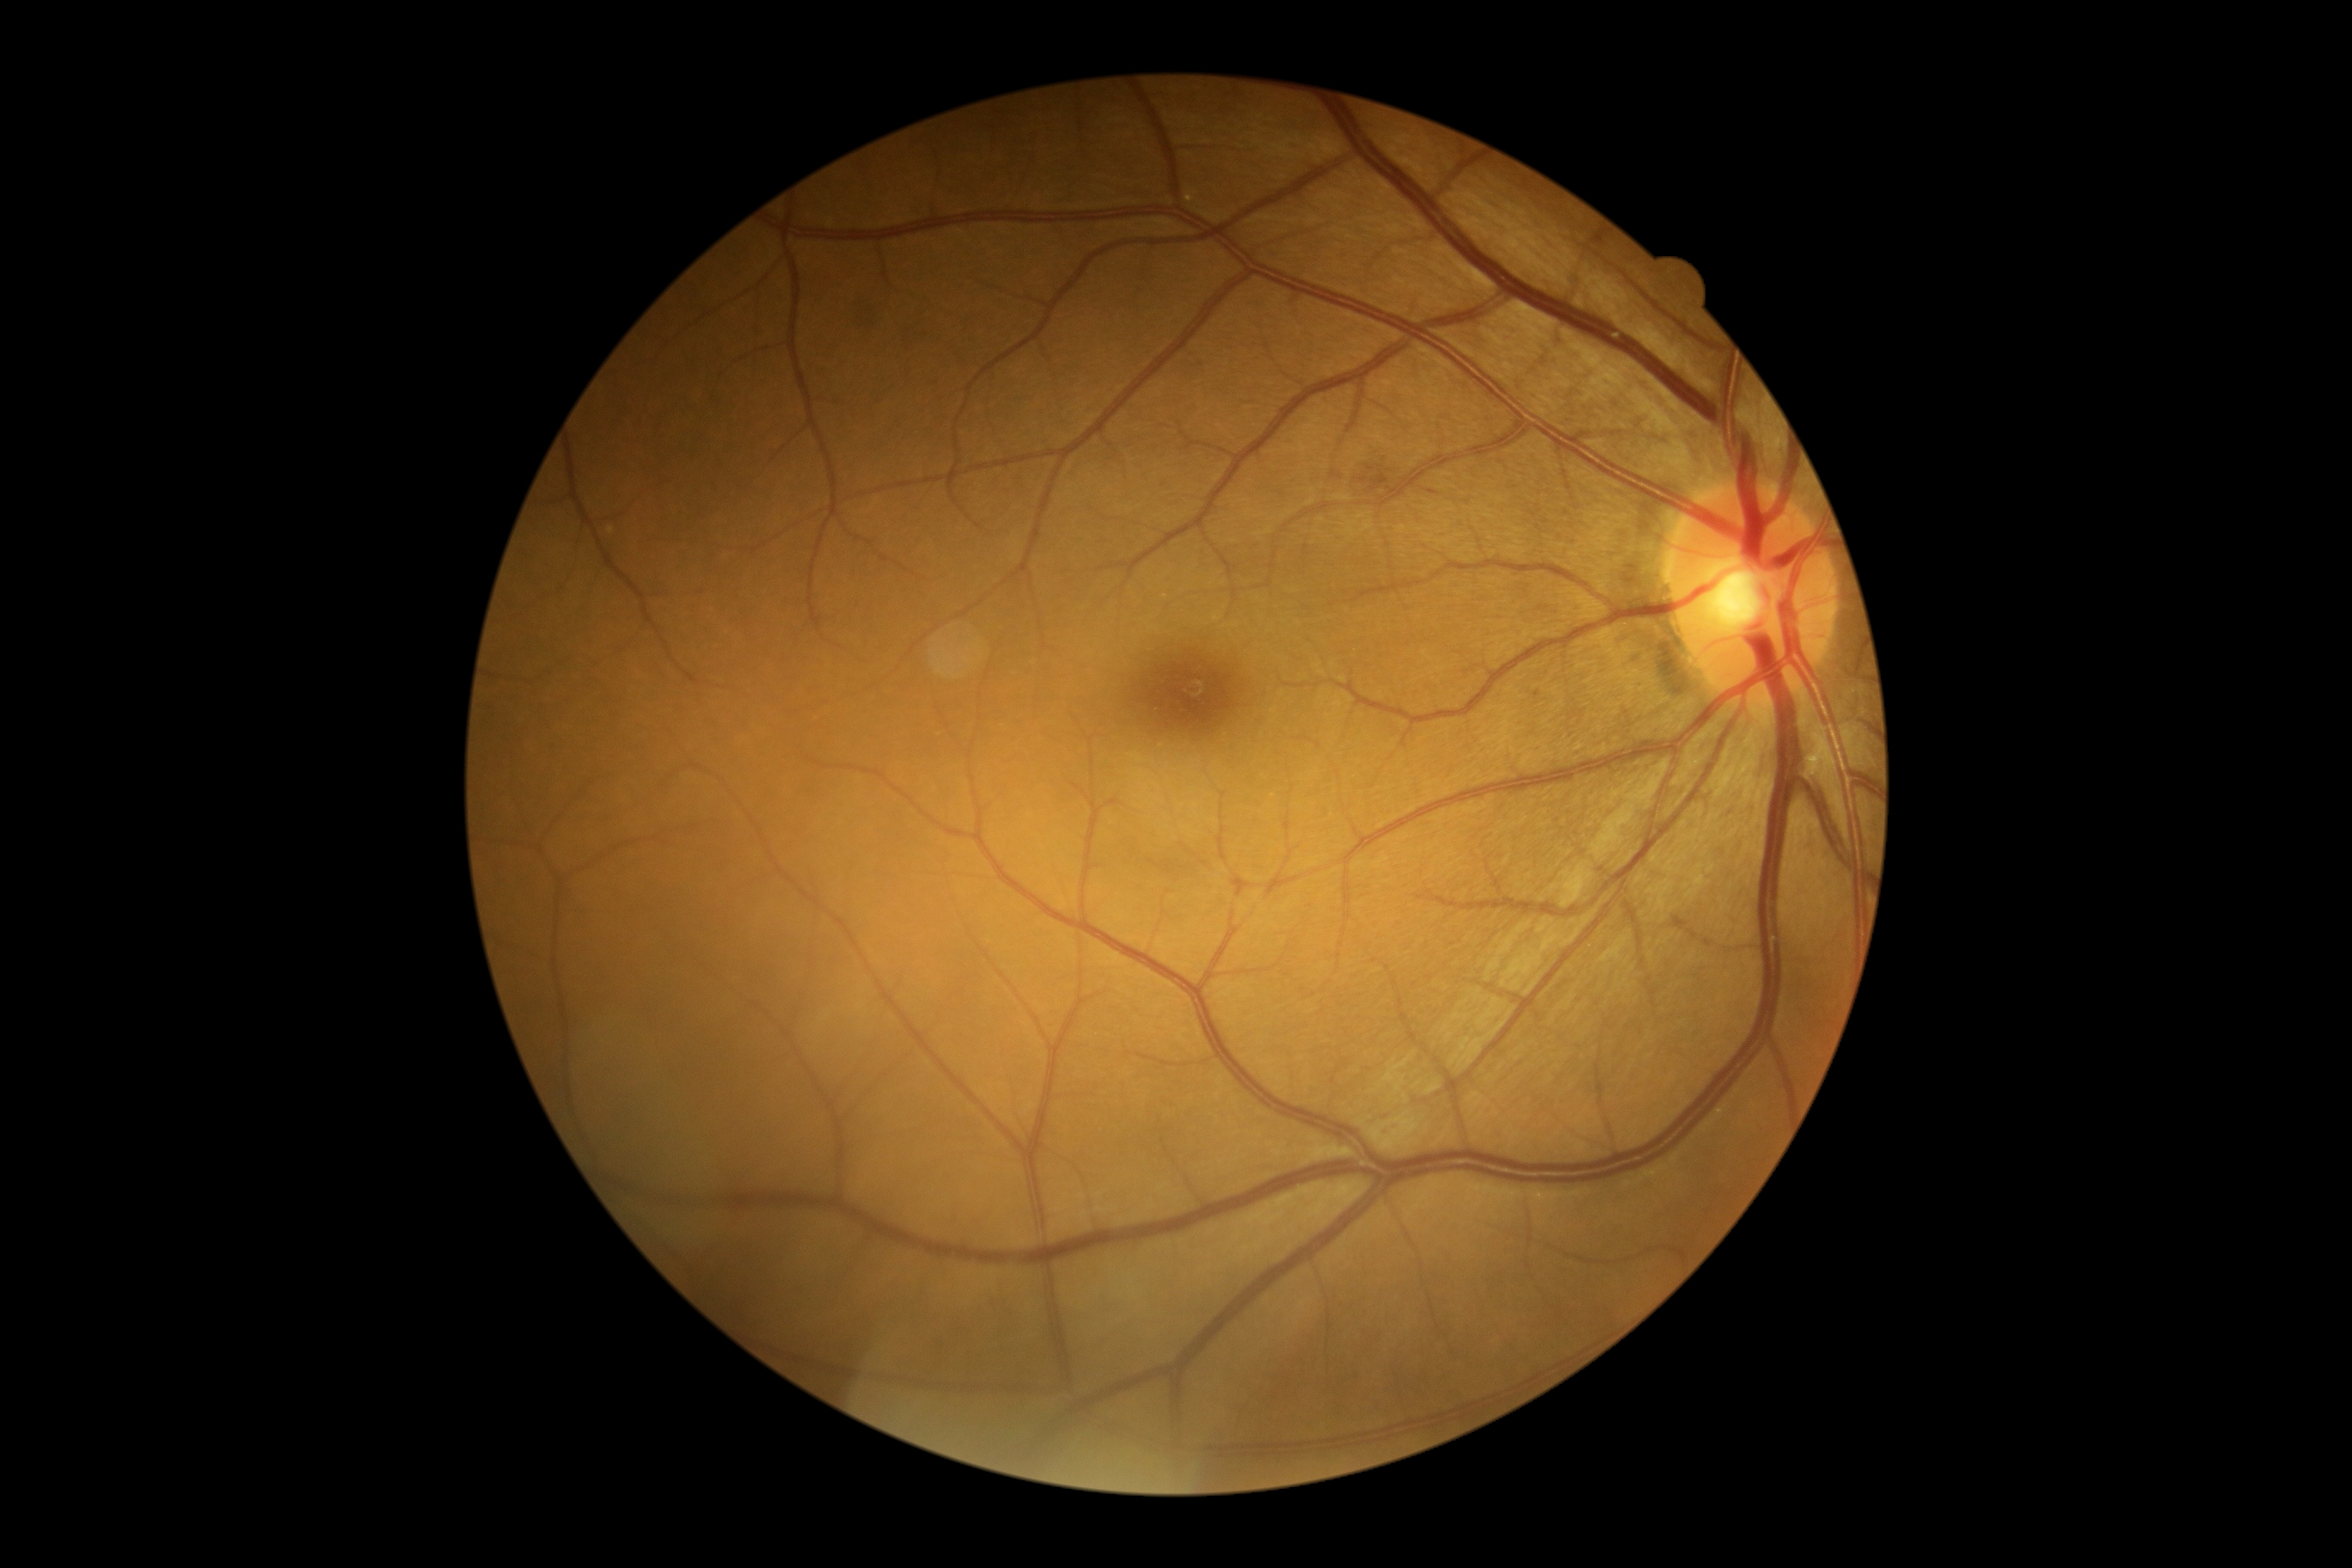 dr_grade: moderate non-proliferative diabetic retinopathy (grade 2)